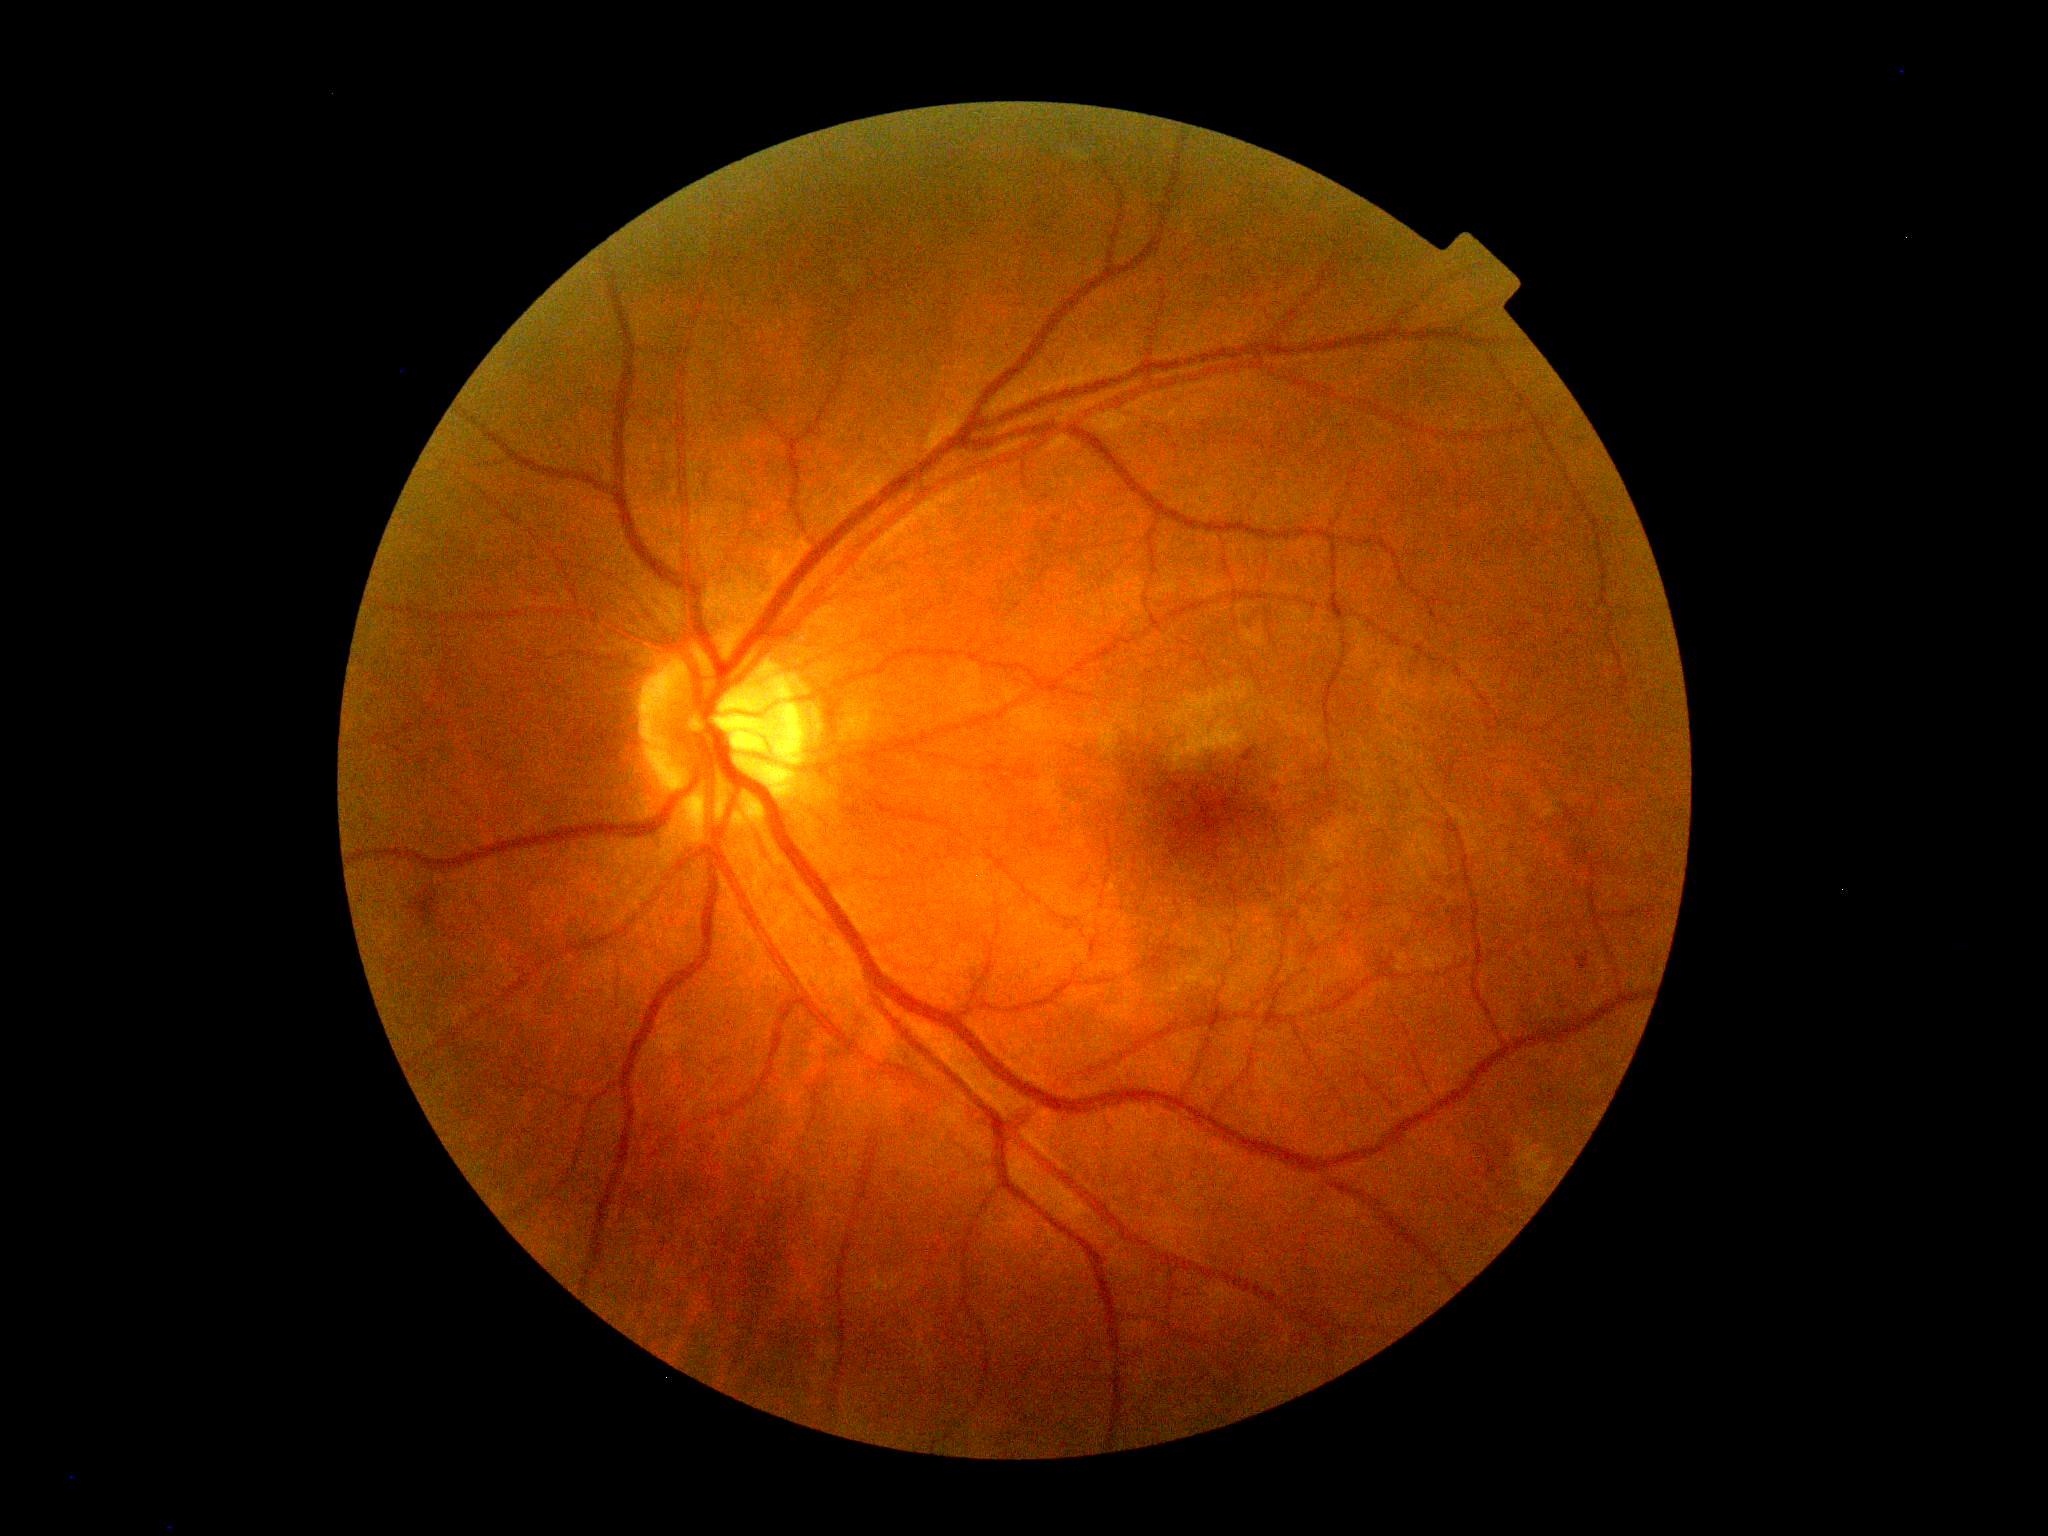 DR stage: 2.